Color fundus photograph. 848 by 848 pixels.
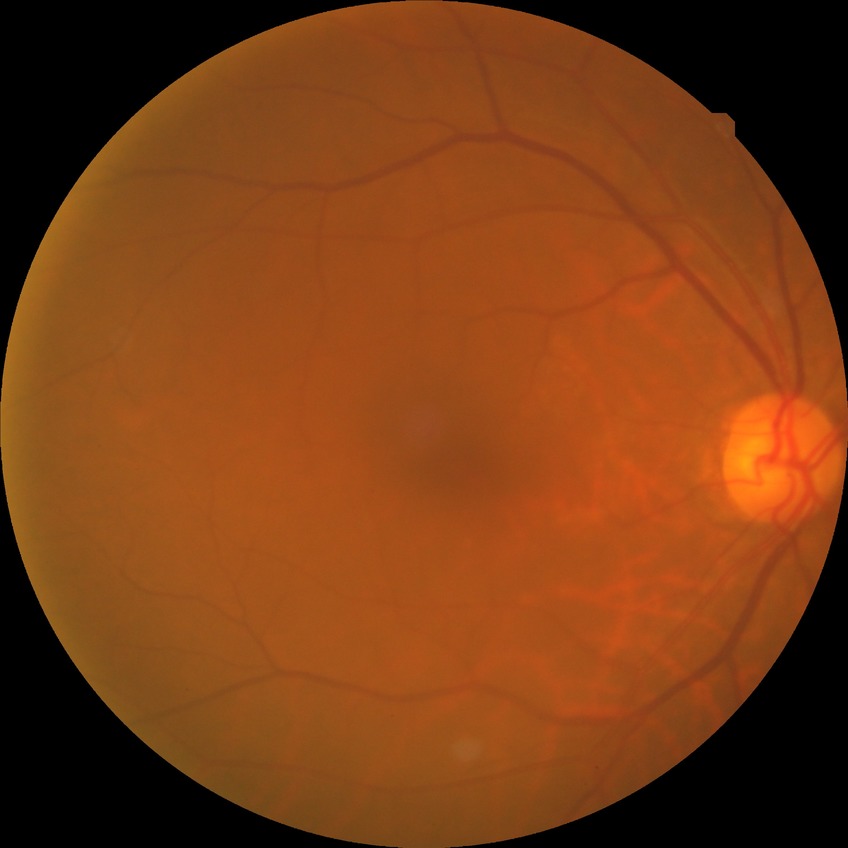
{
  "davis_grade": "NDR",
  "dr_impression": "no signs of DR"
}